Color fundus image. Posterior pole field covering the optic disc and macula. Camera: Topcon TRC-50DX. 50° field of view:
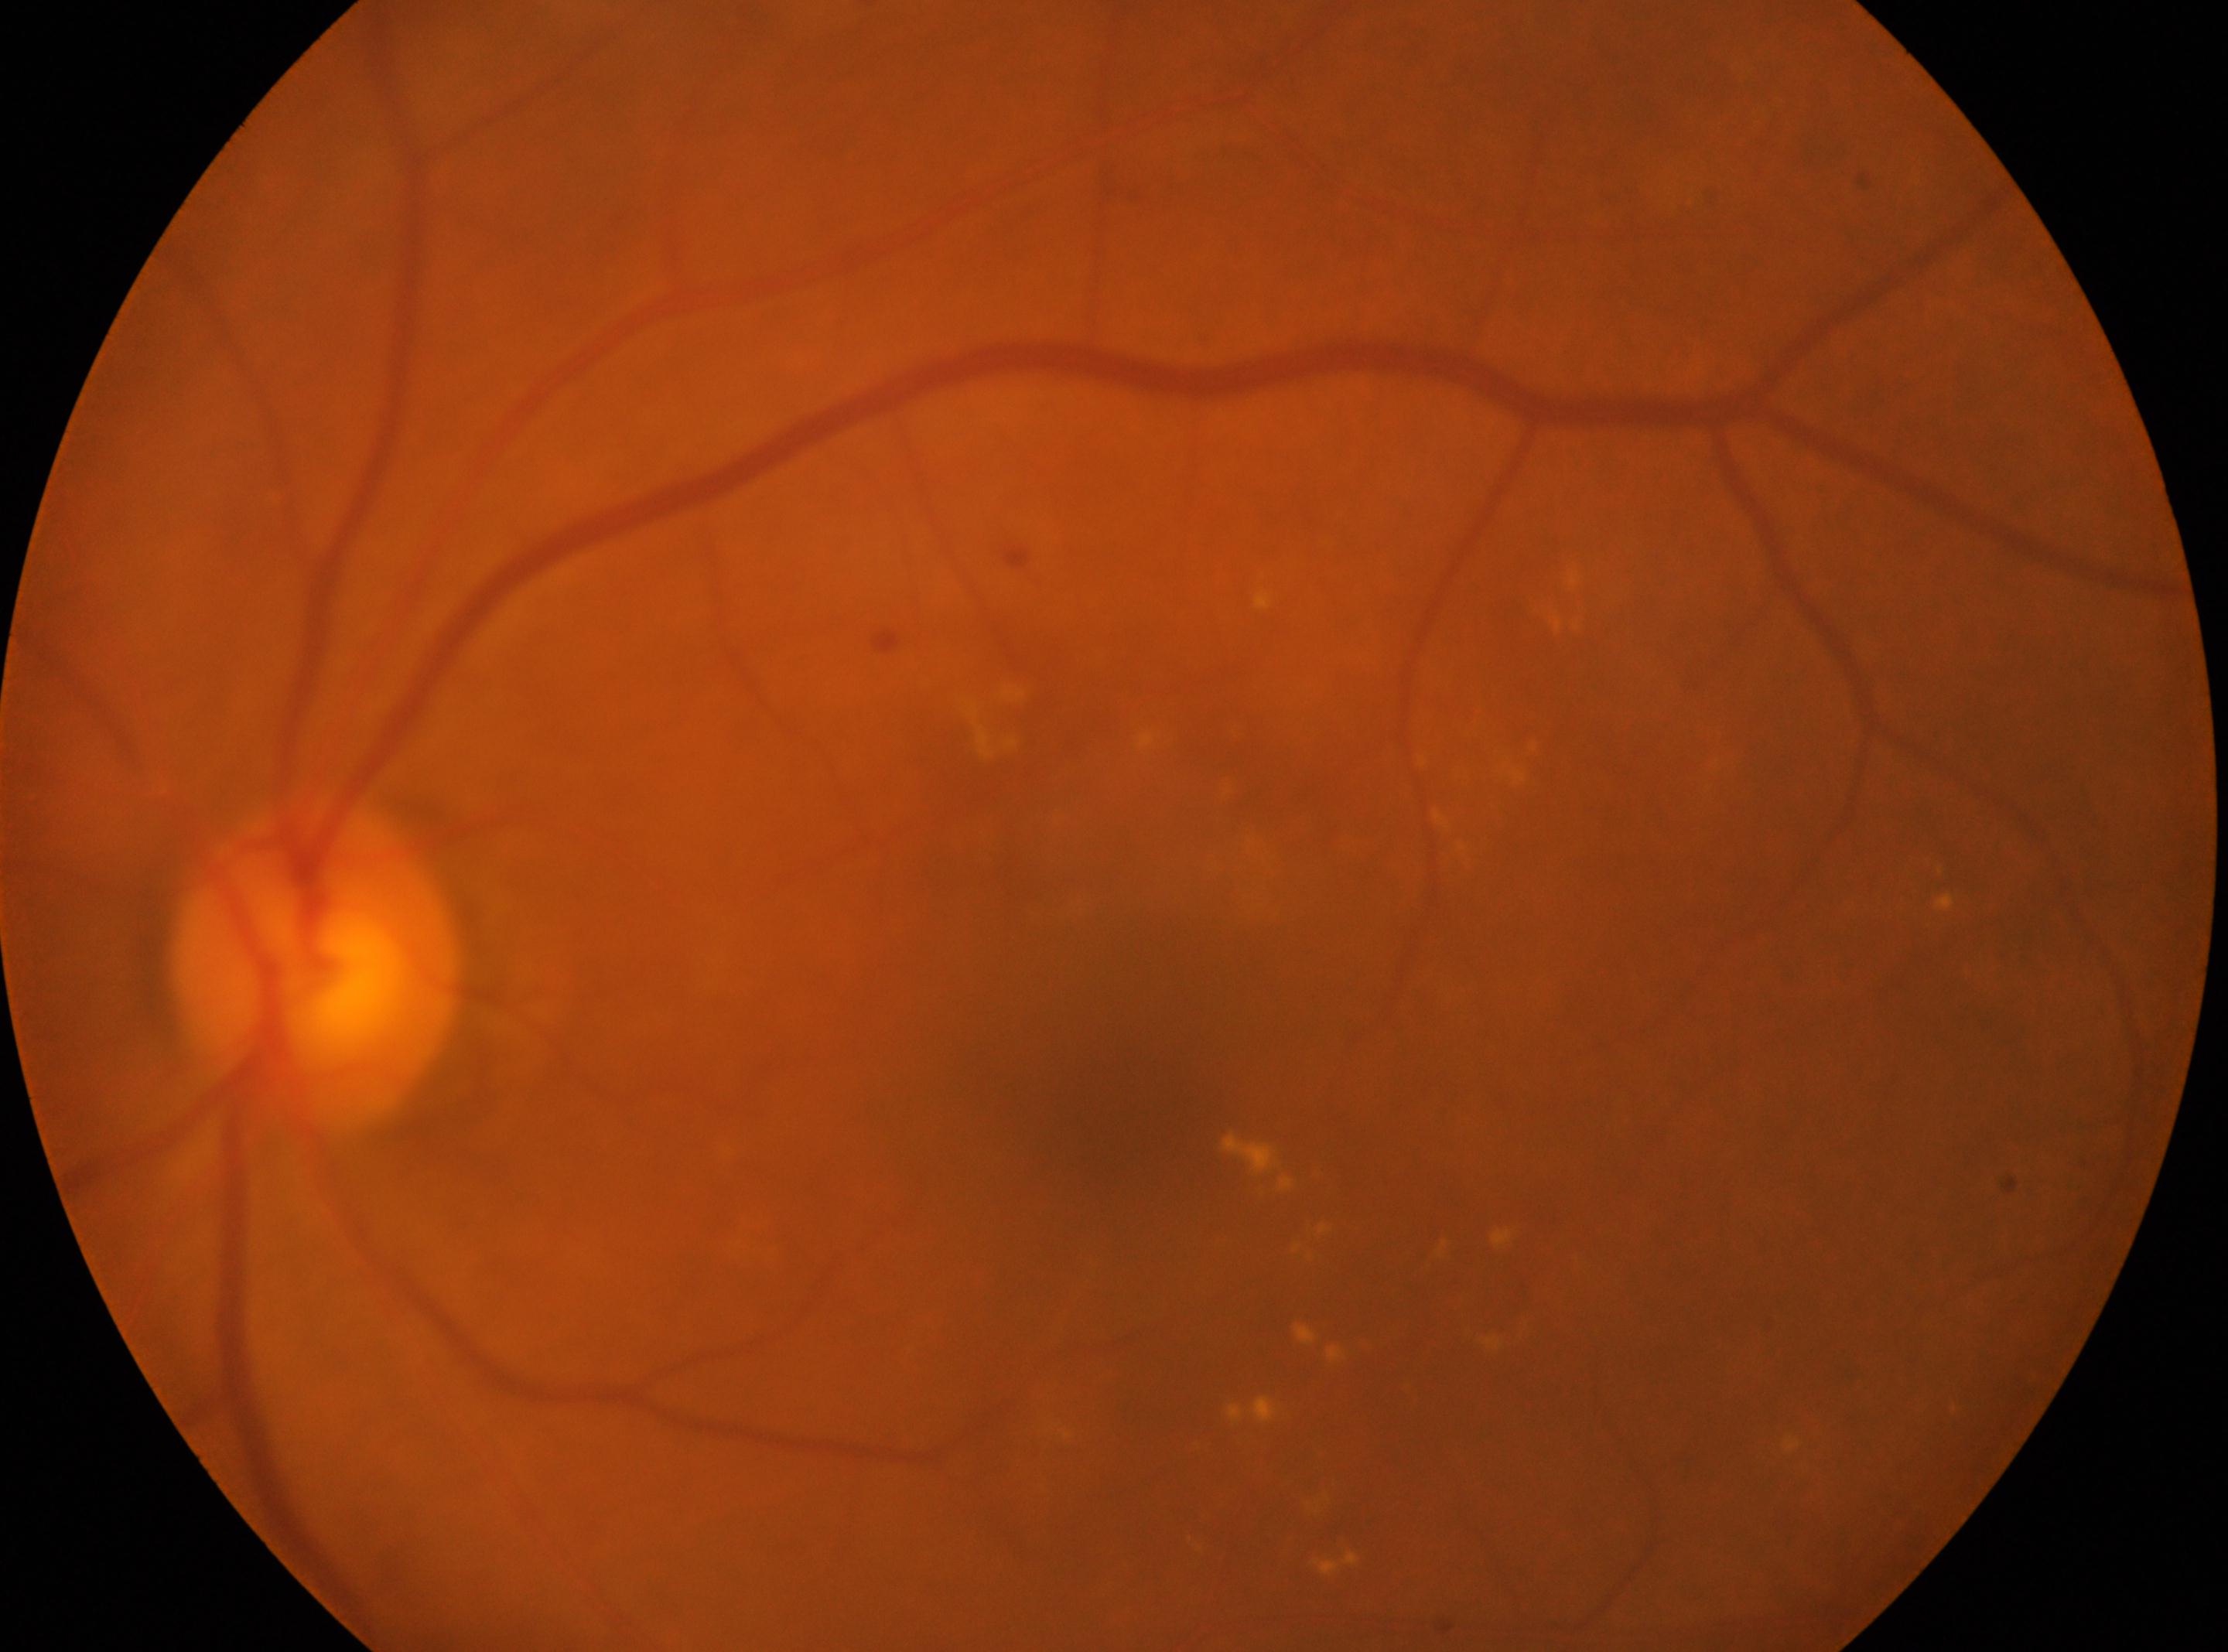
The macula center is at (1125,1118). Optic disc located at (314,965). DR severity is moderate non-proliferative diabetic retinopathy (grade 2). Eye: oculus sinister.